2352x1568px · retinal fundus photograph · 45° field of view: 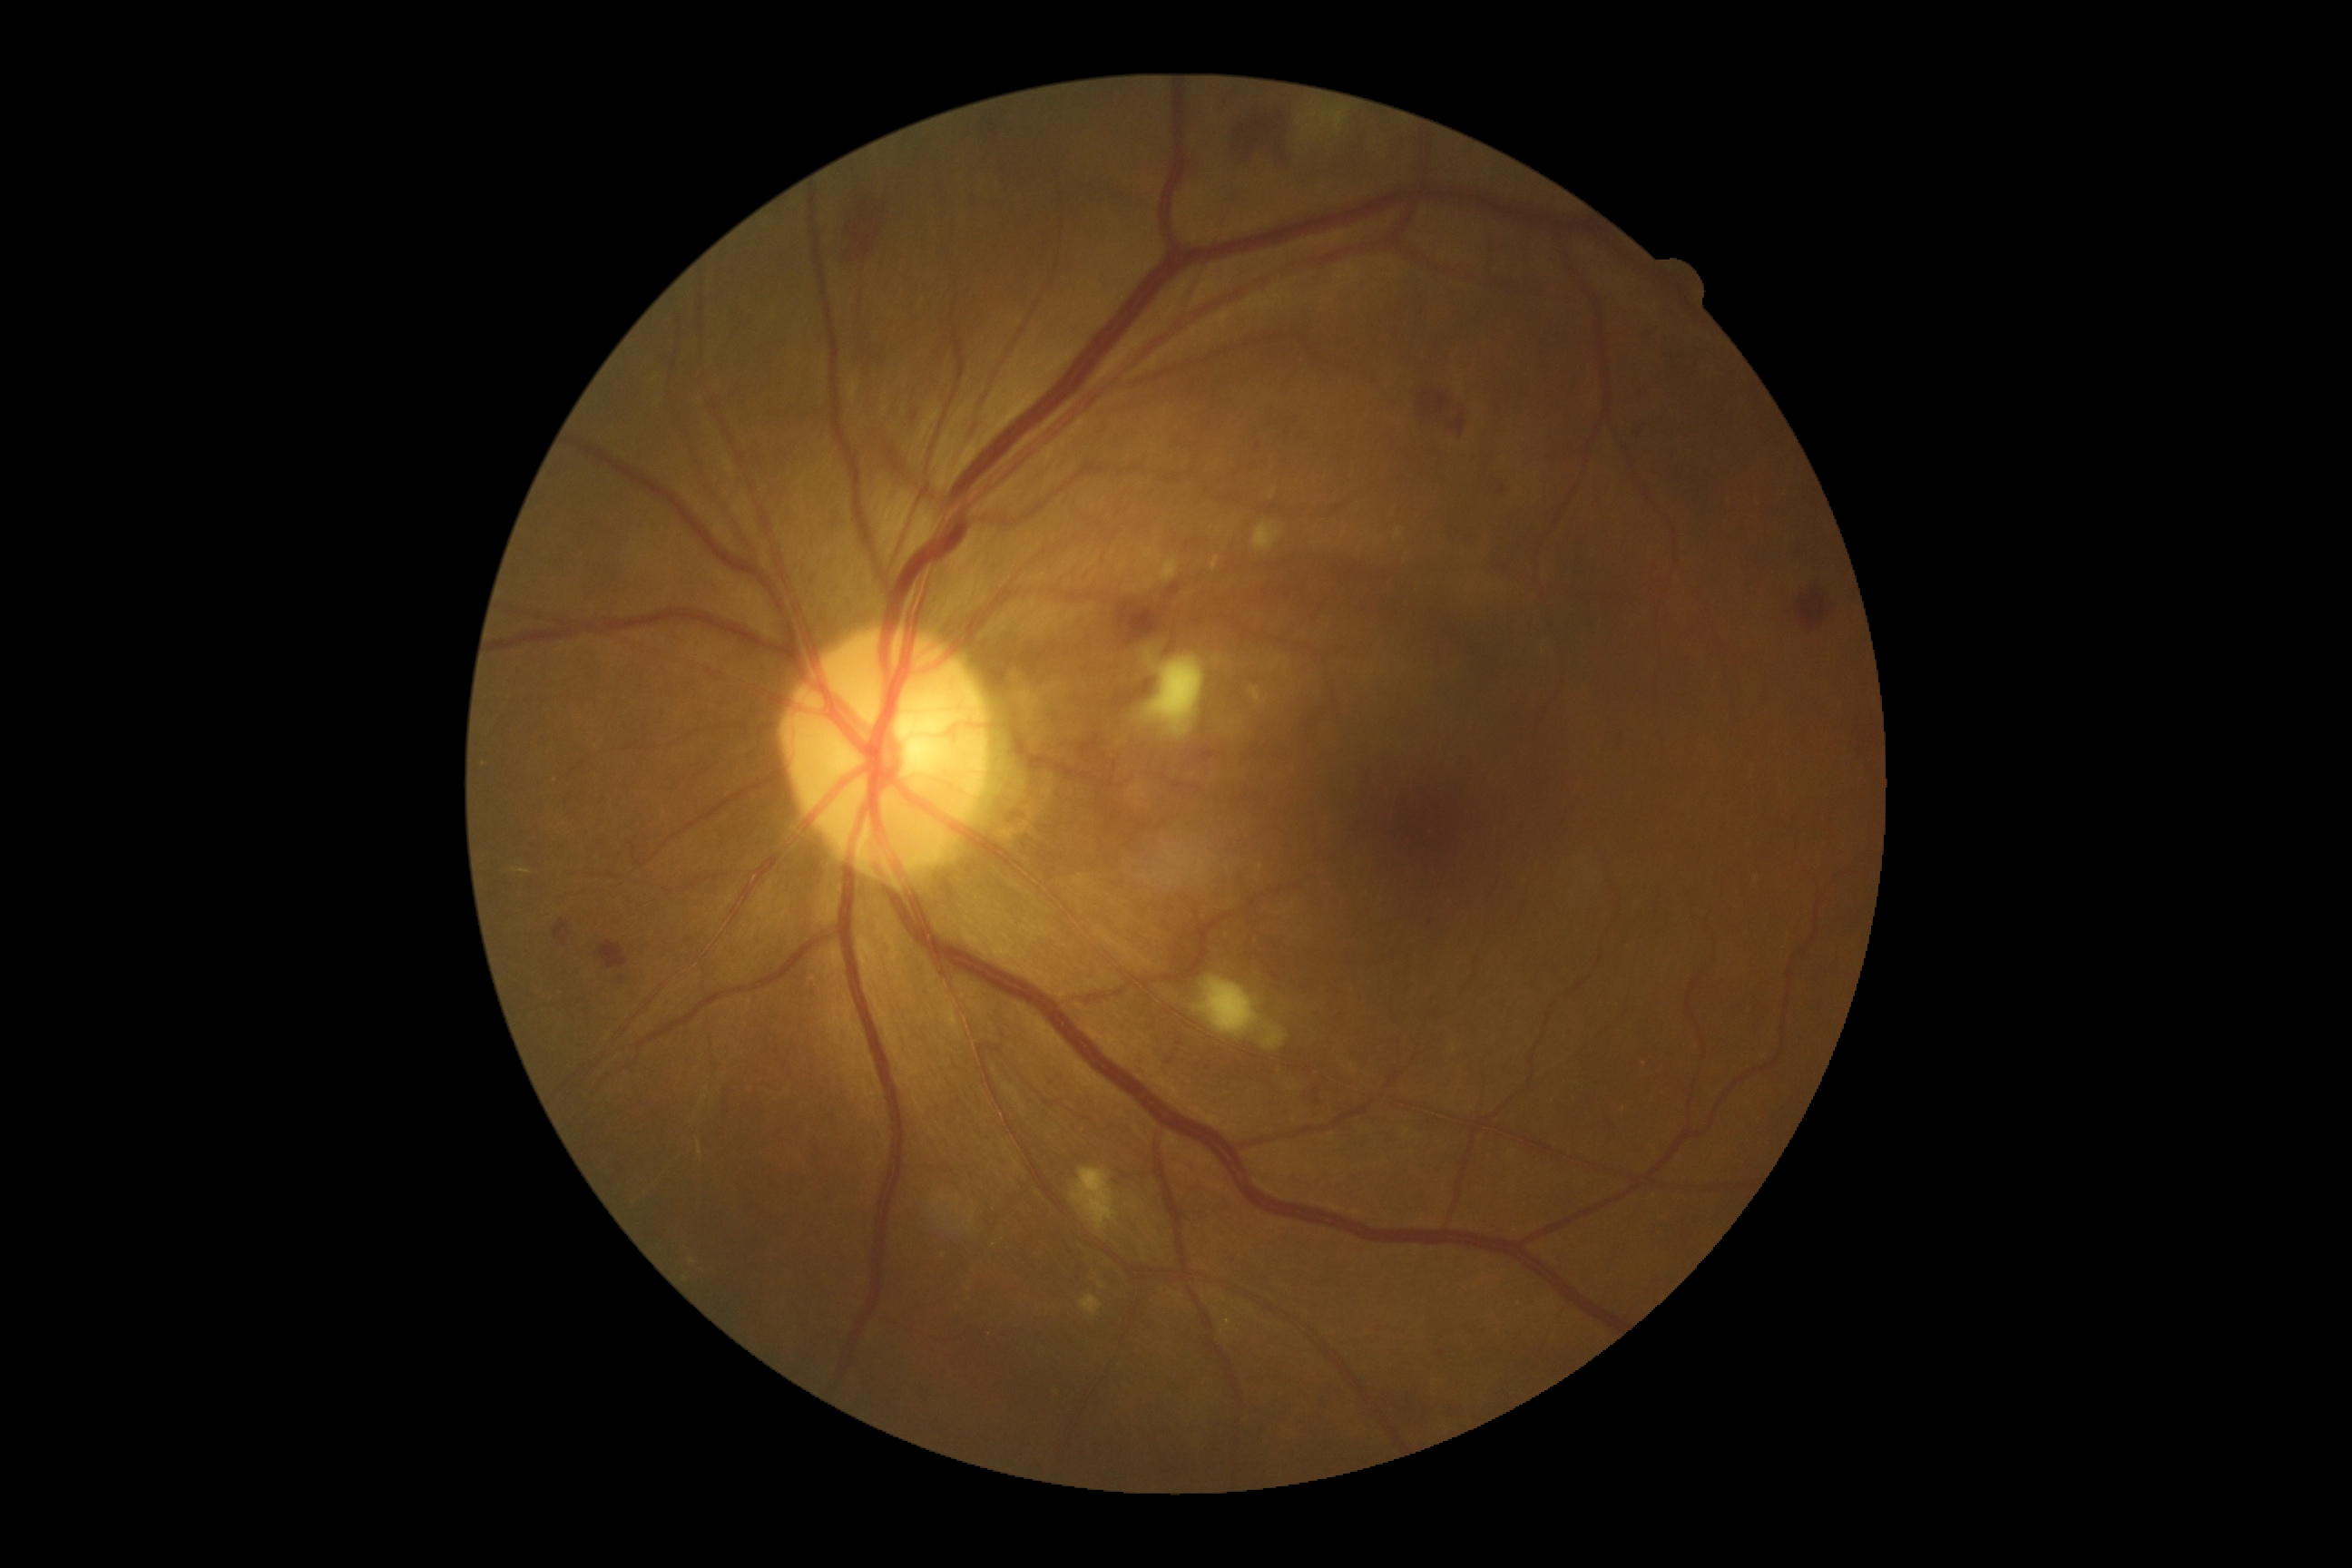 Diabetic retinopathy is grade 2 (moderate NPDR) — more than just microaneurysms but less than severe NPDR. Soft exudates at 1264,1026,1288,1050 | 1295,103,1349,162 | 1195,975,1260,1037 | 1146,658,1204,738 | 1079,1295,1102,1317 | 1072,1168,1119,1233 | 1251,524,1284,553. No microaneurysms identified. No hard exudates identified. Hemorrhages at 1124,612,1161,643 | 1438,1351,1446,1358 | 1195,747,1219,761 | 910,411,919,422 | 1230,104,1295,168 | 1792,589,1834,631 | 845,190,877,270 | 553,919,571,946 | 1494,484,1505,500 | 1418,386,1471,436 | 598,941,629,970 | 1634,426,1643,436.